Optic disc photograph, image size 475x475, acquired with a Topcon TRC: 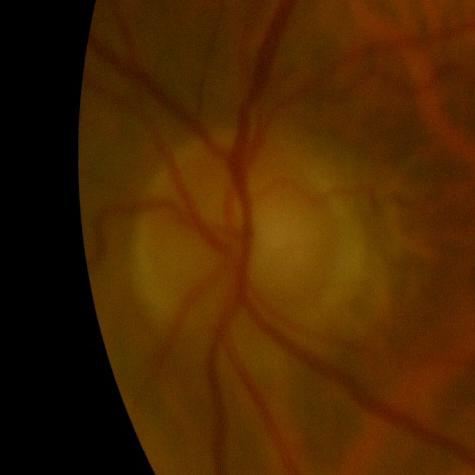 Showing no glaucoma.